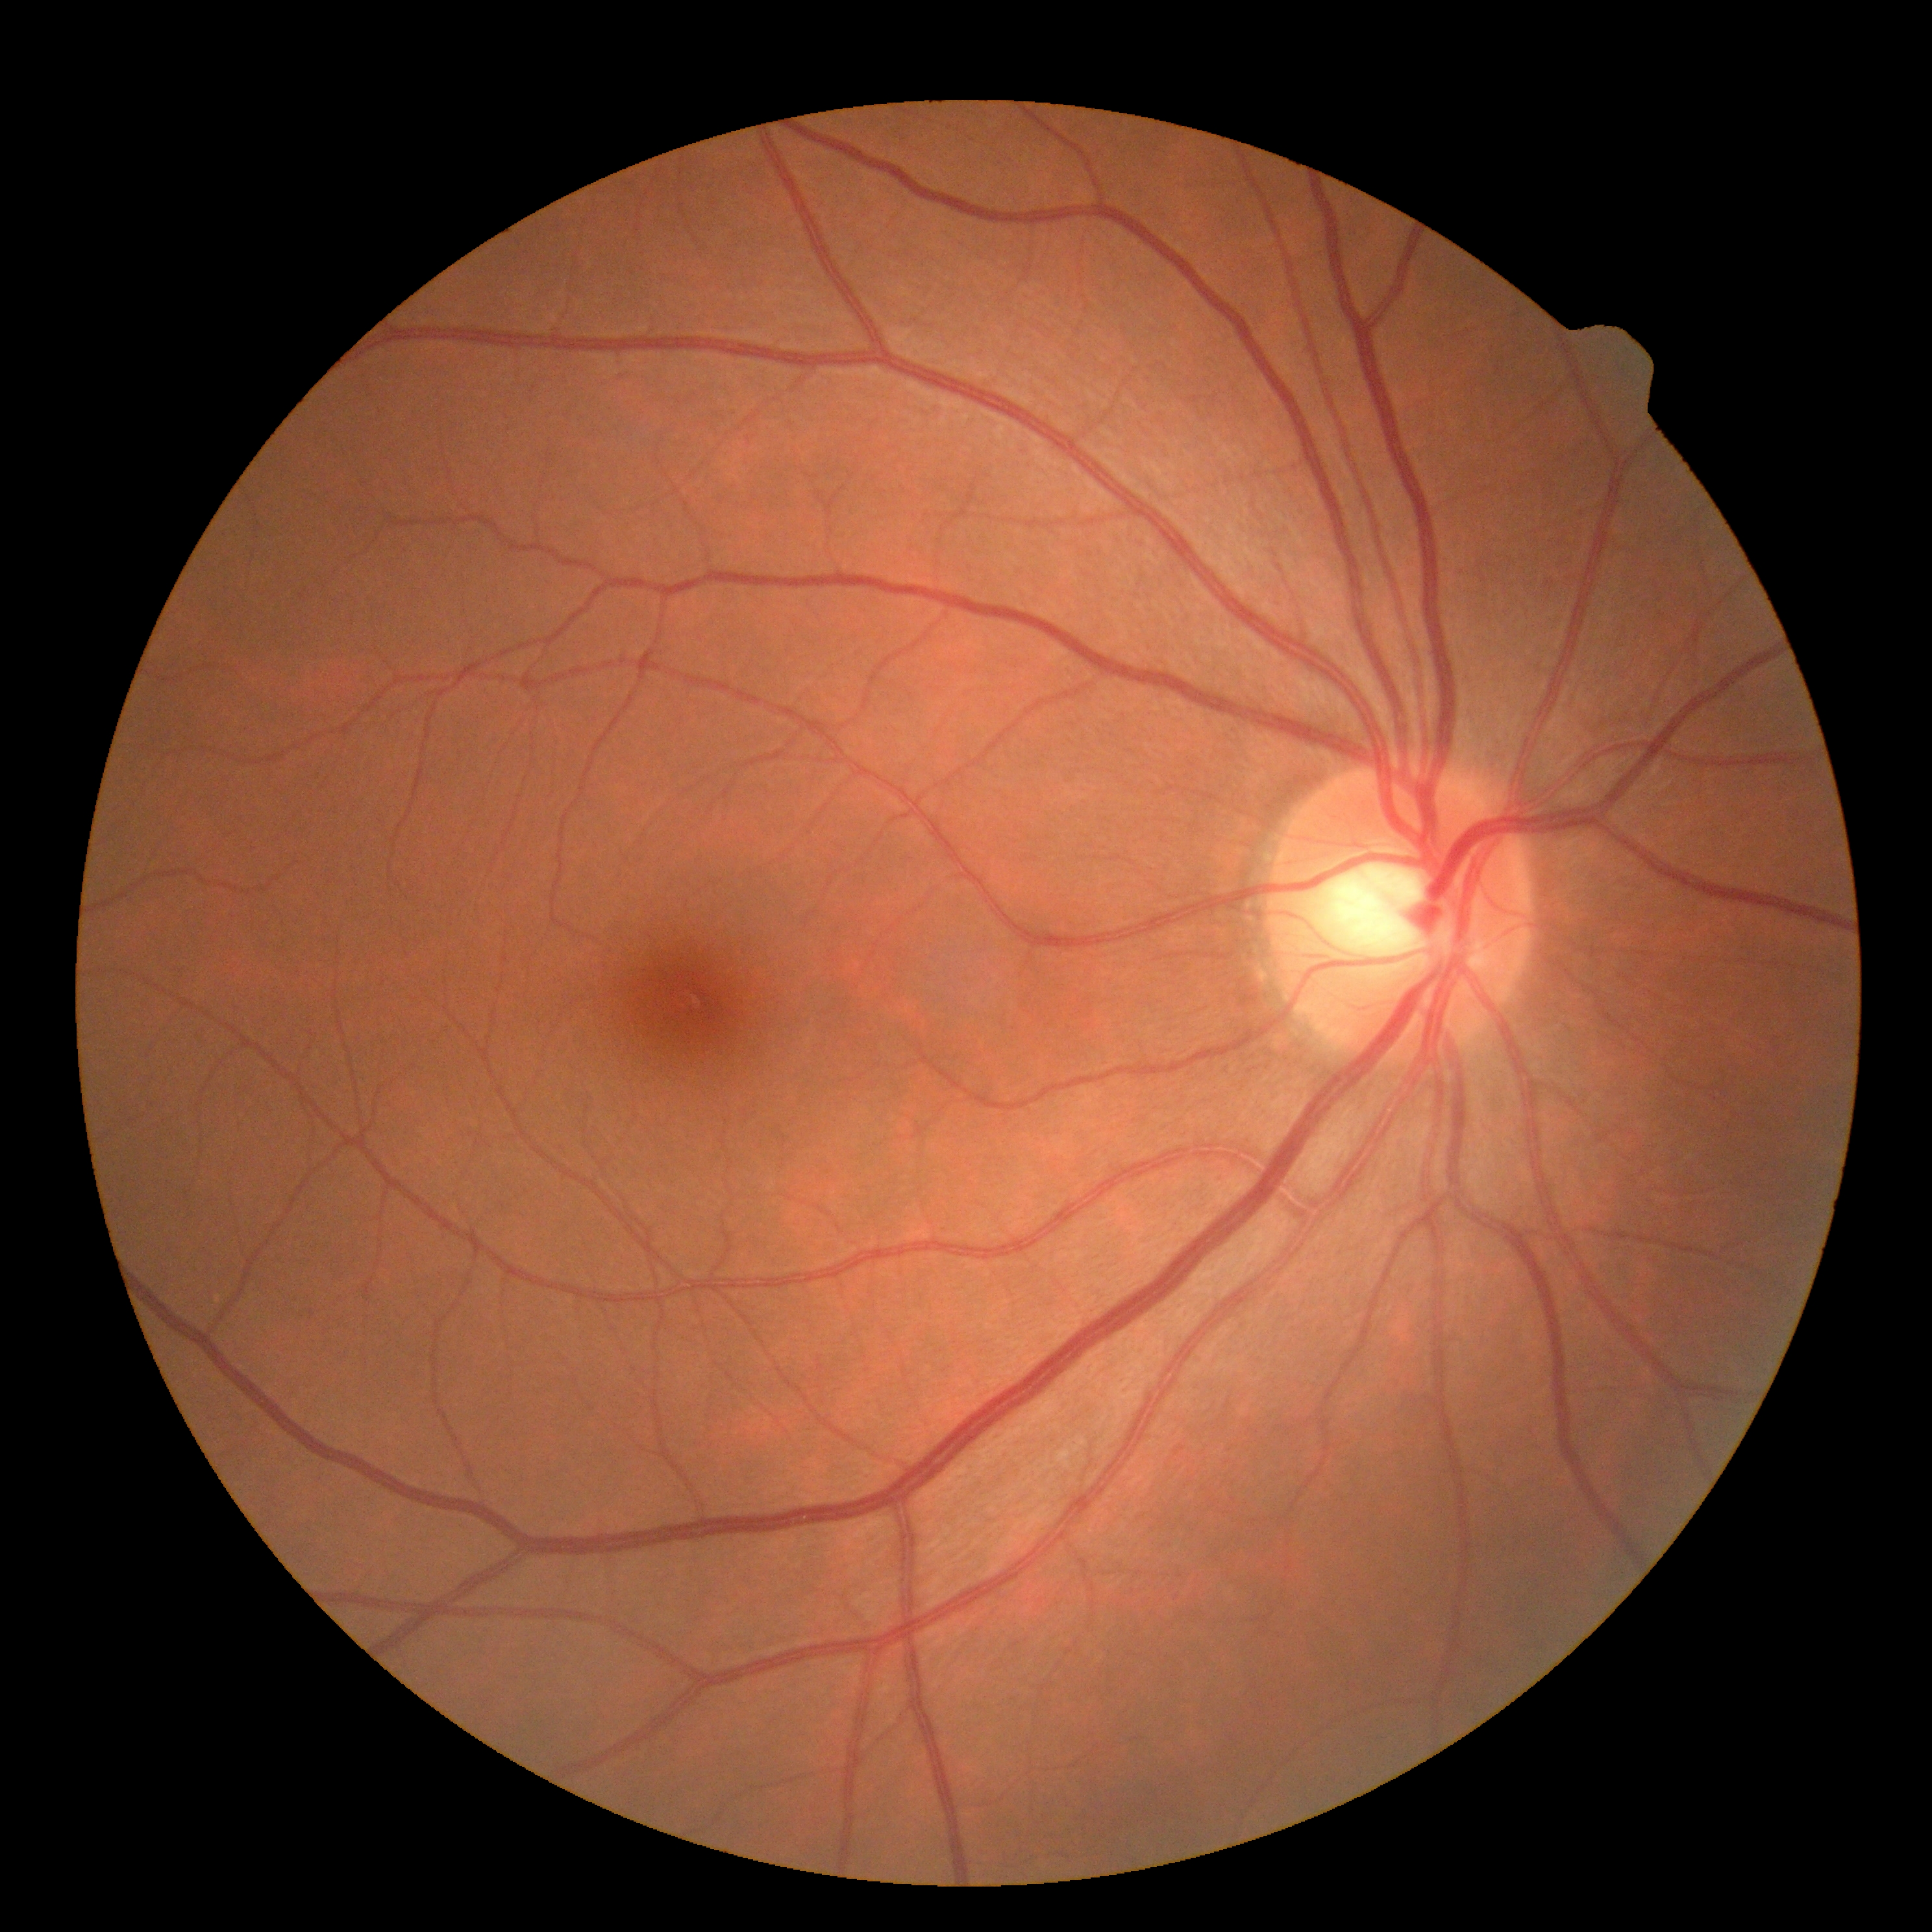
Diabetic retinopathy severity is grade 0 (no apparent retinopathy).